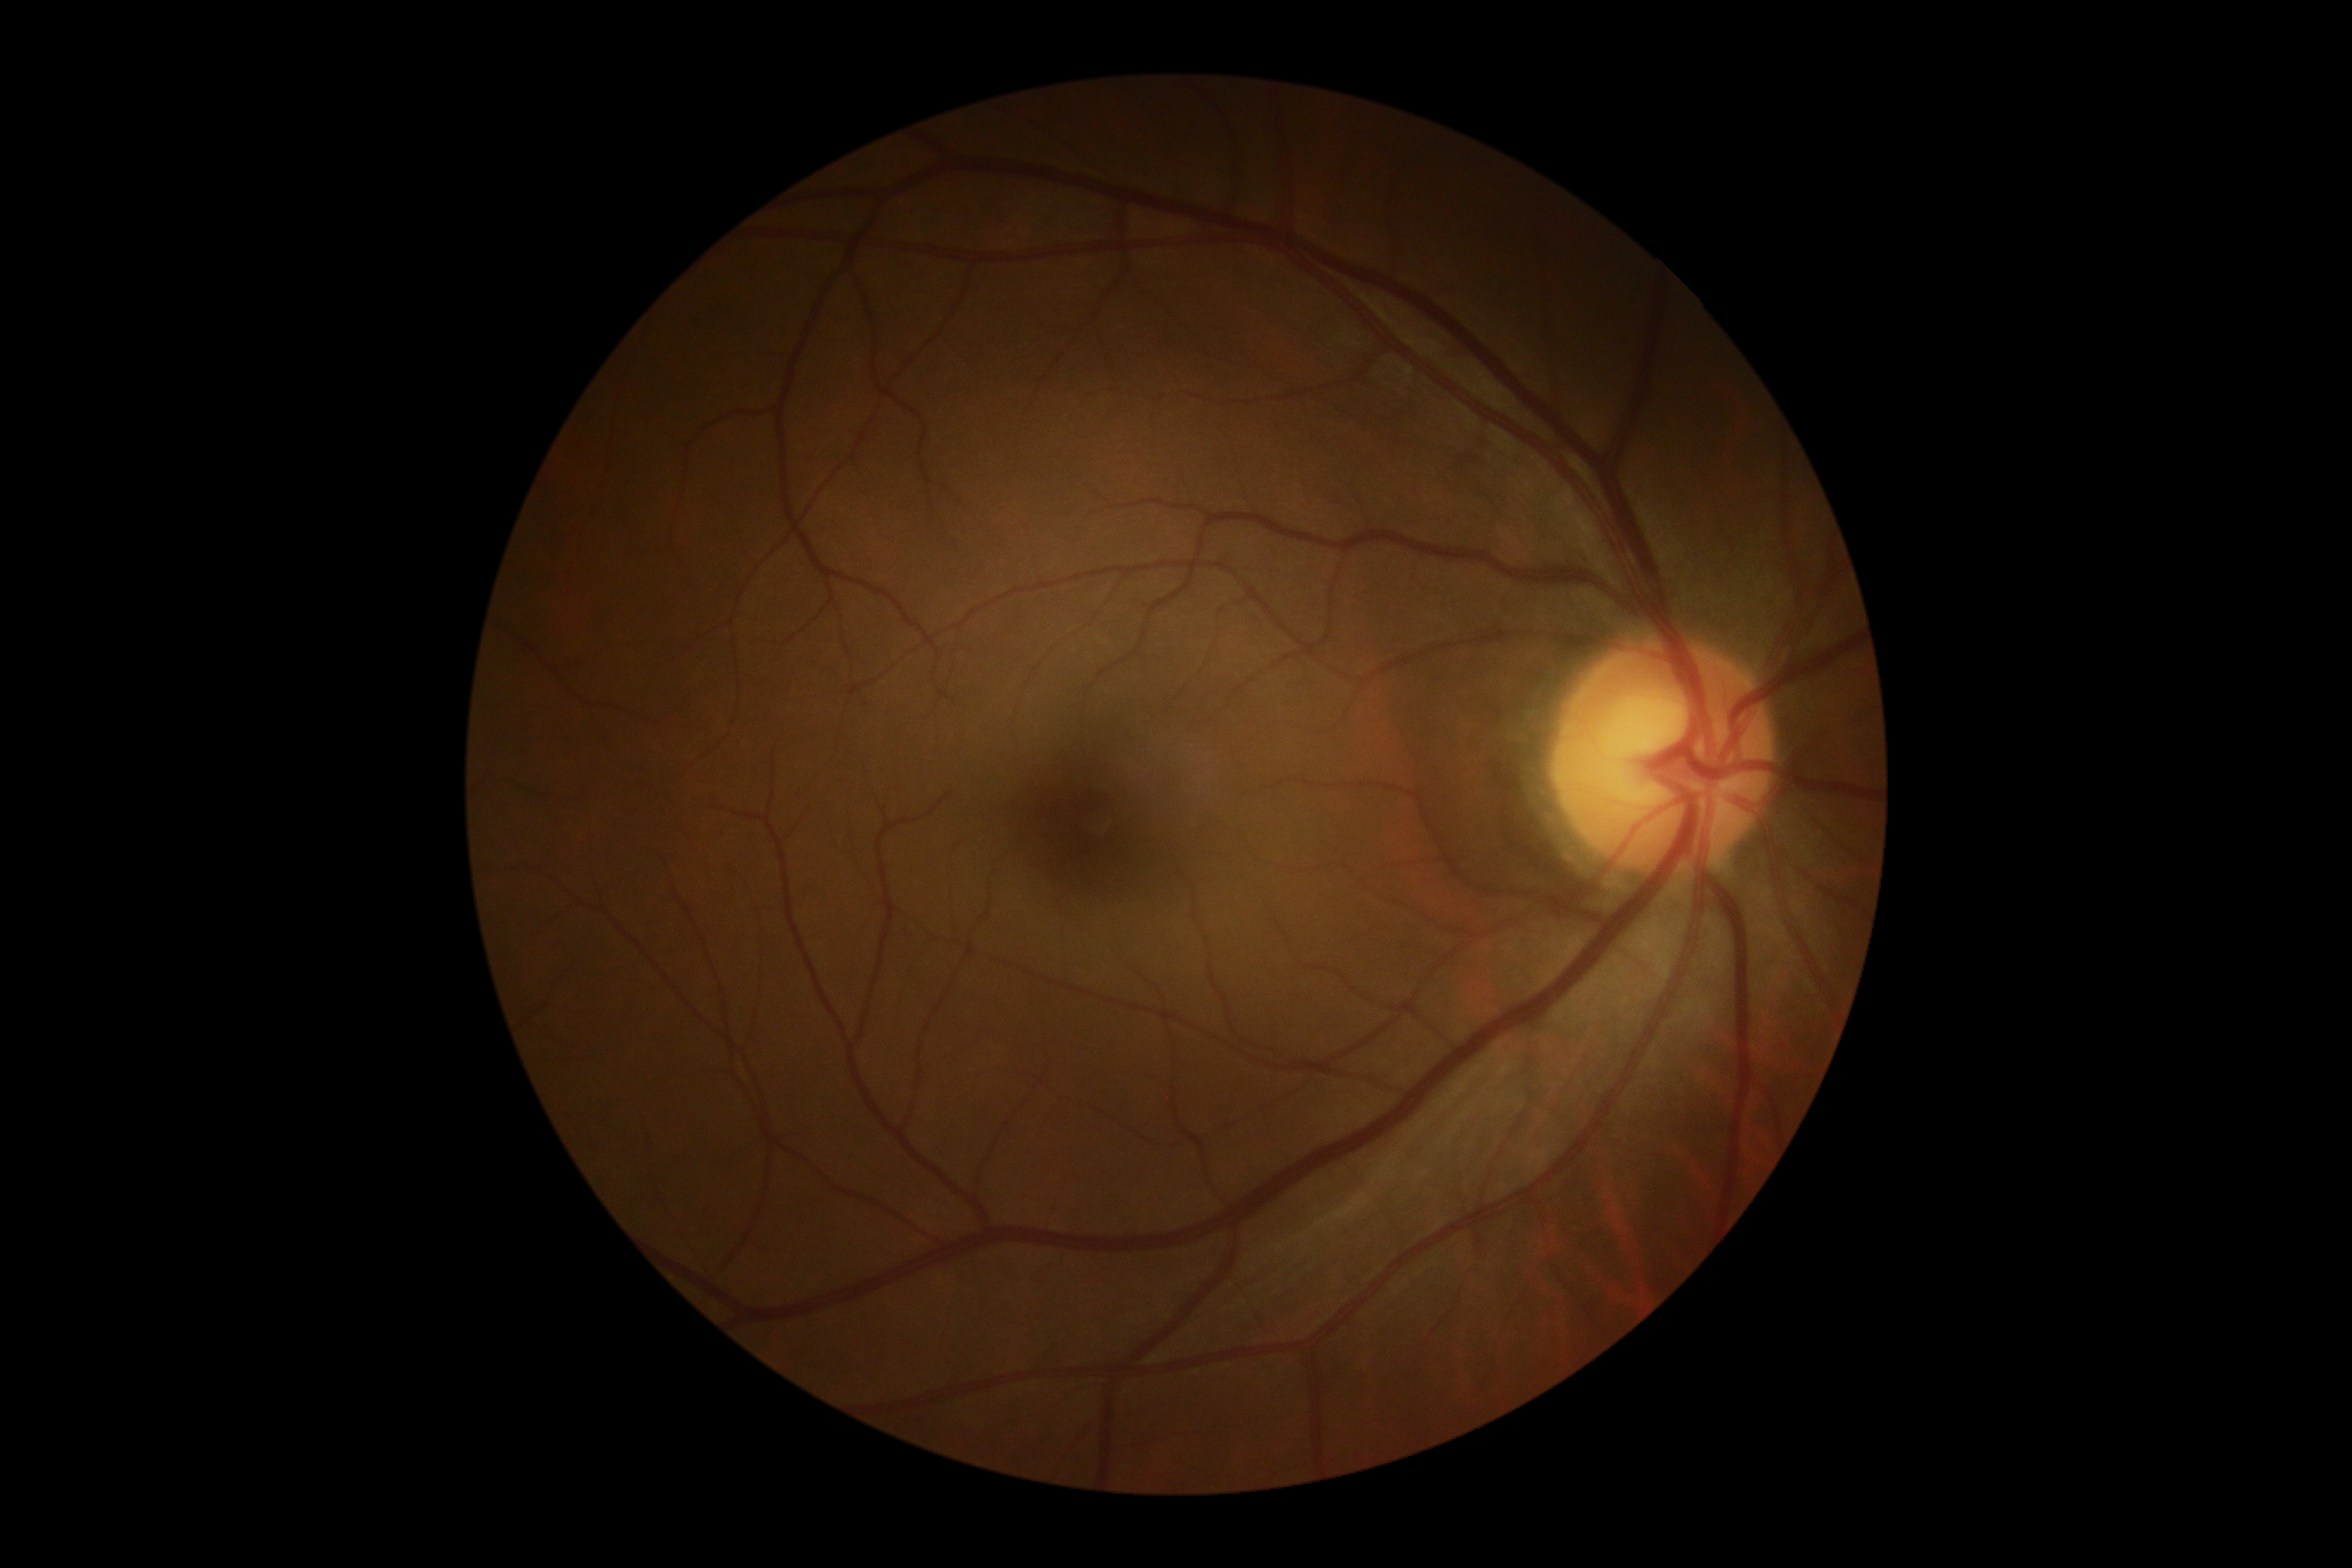
DR severity: 0.